512x512.
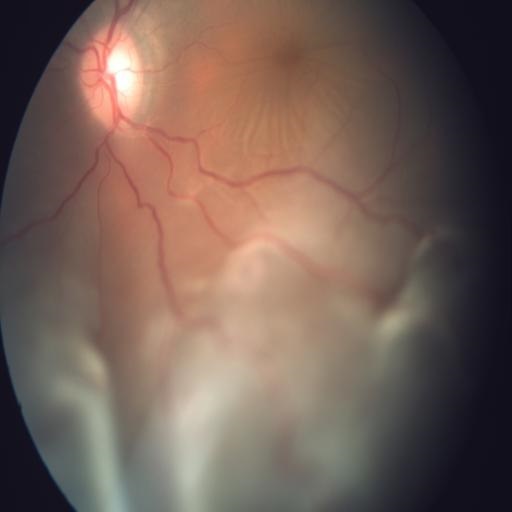
Impression: retinal detachment (RD).